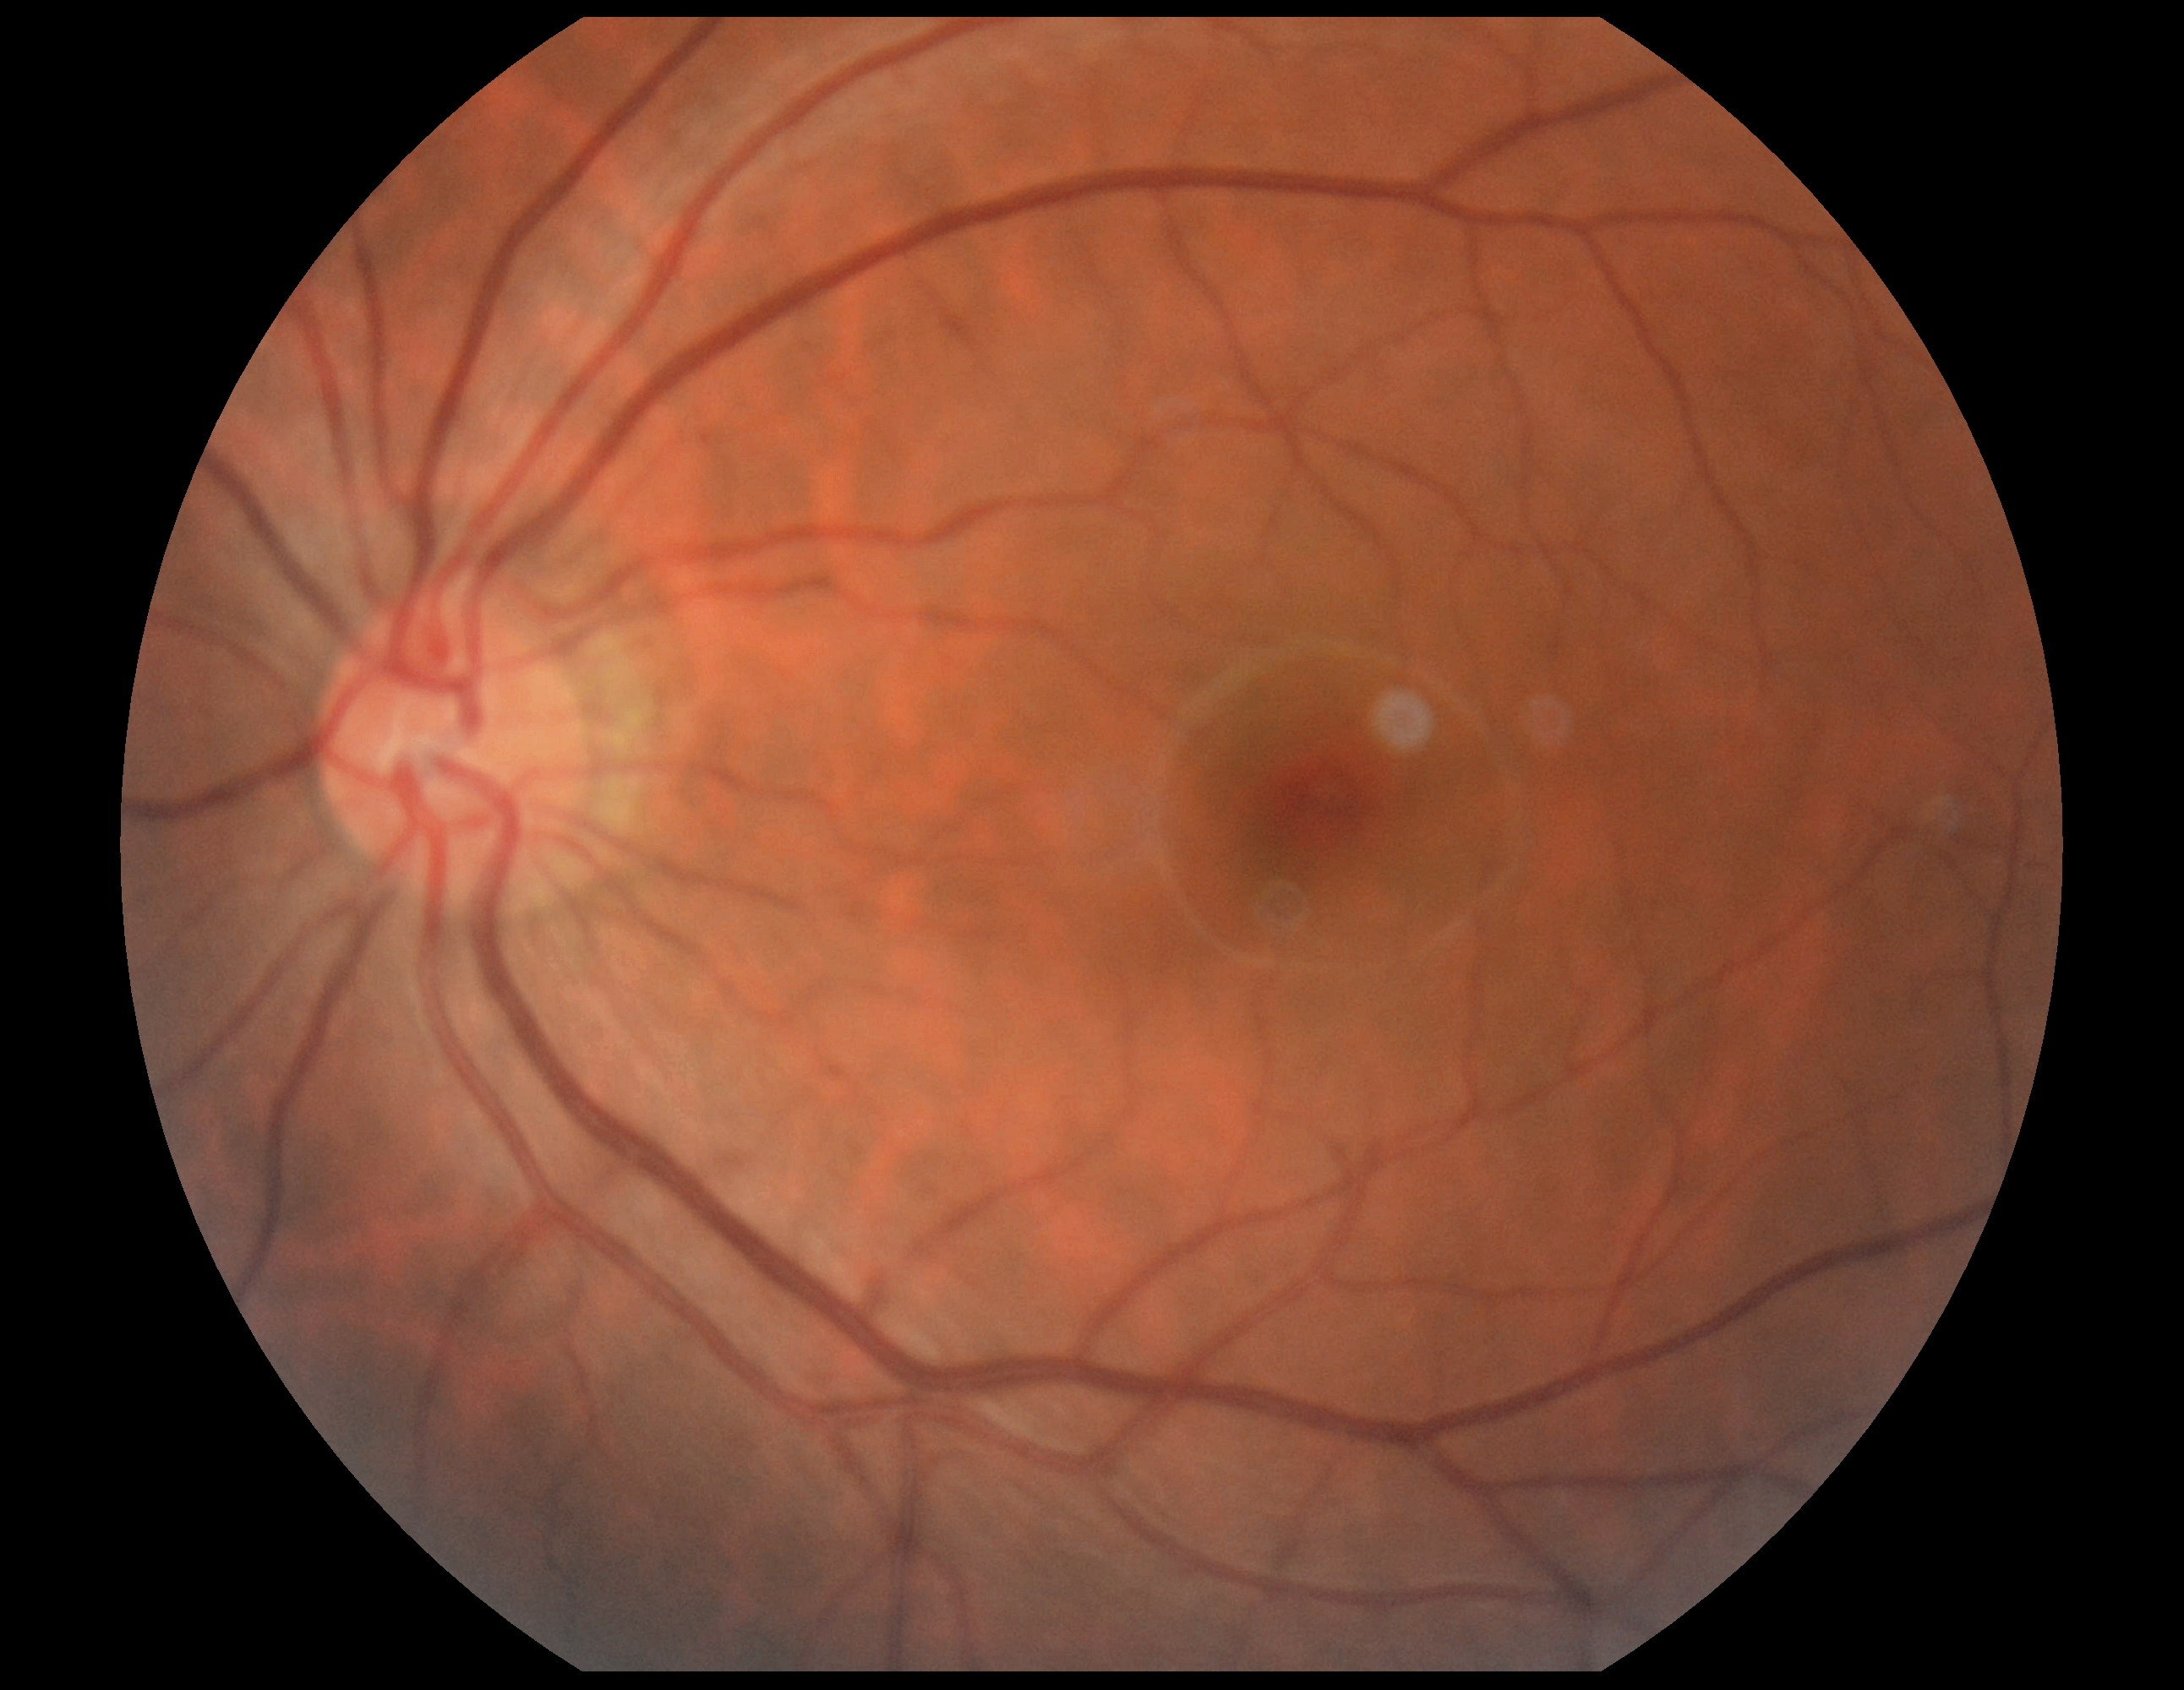
DR impression@no apparent DR; retinopathy grade@0/4 — no visible signs of diabetic retinopathy.